512x512. Color fundus photograph:
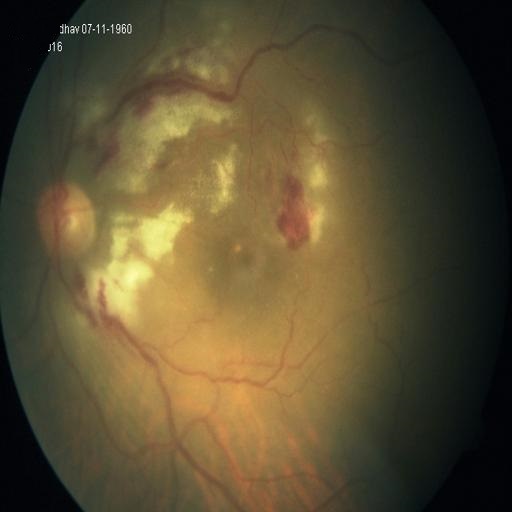
Diagnosis: retinitis.